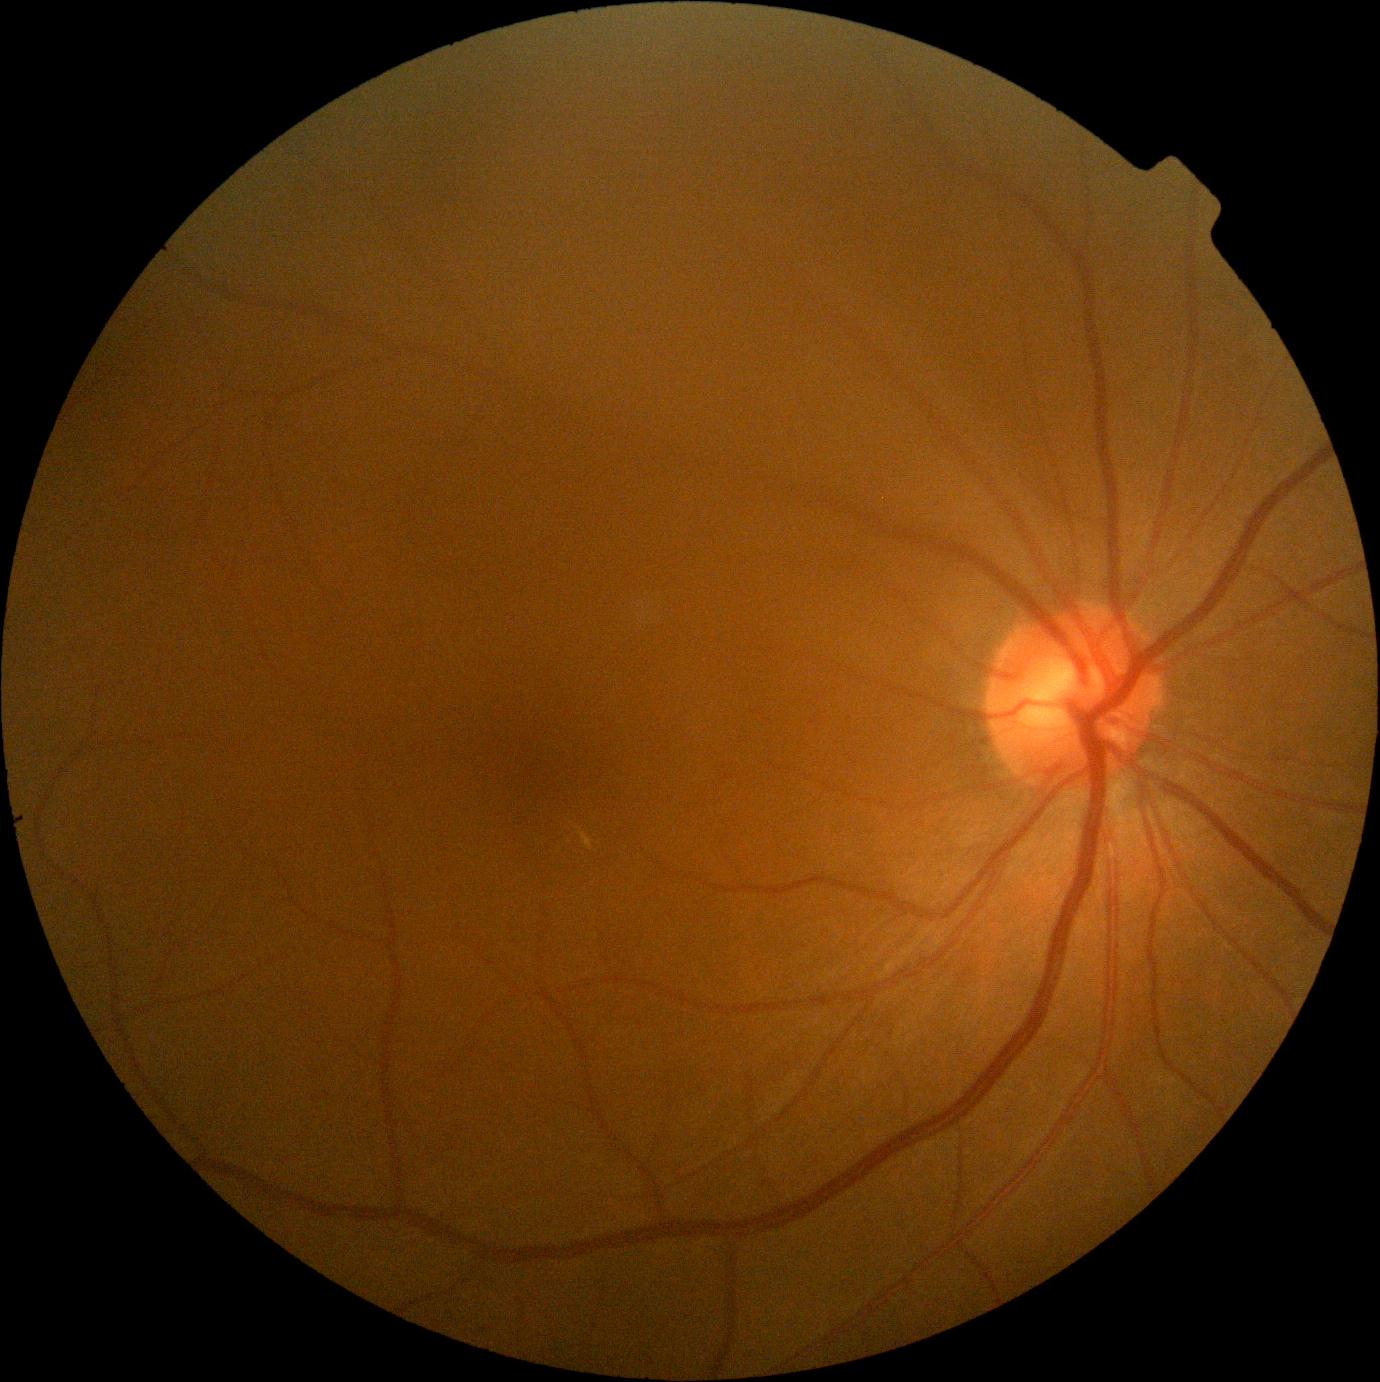 Findings:
– DR stage — 0